Wide-field fundus image from infant ROP screening; captured with the Clarity RetCam 3 (130° field of view)
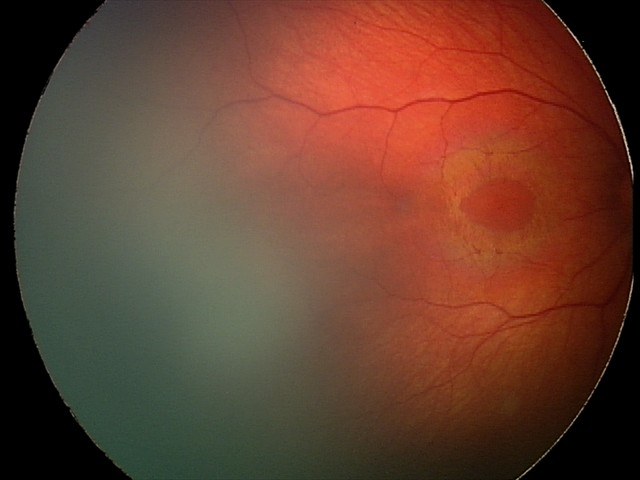

Impression: retinal hemorrhages.